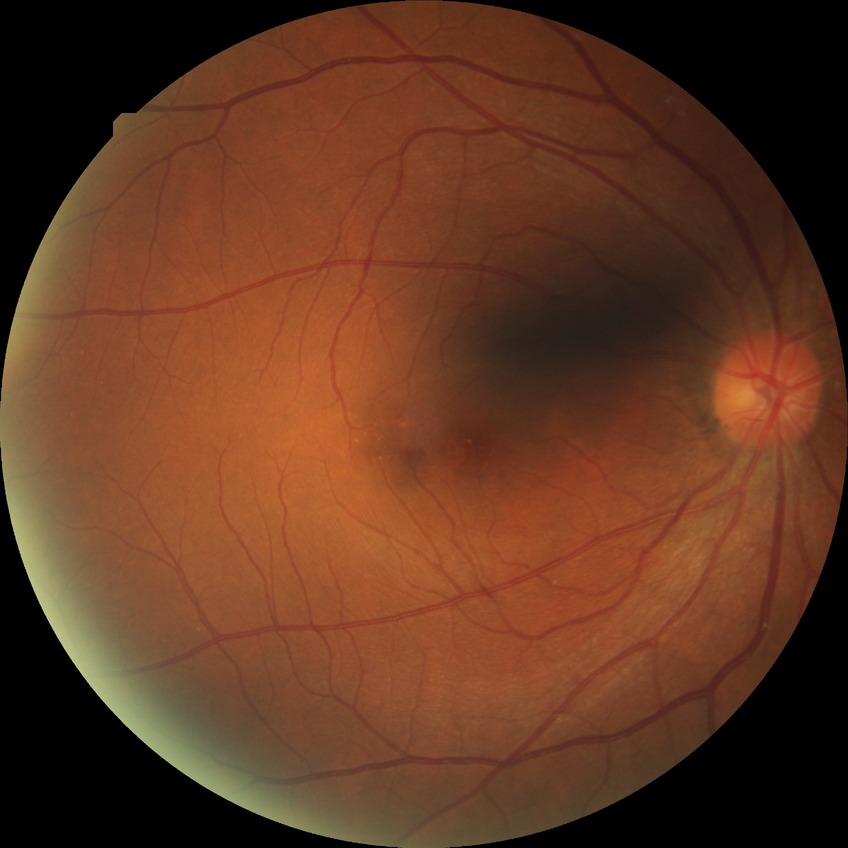

modified Davis classification@no diabetic retinopathy.